Wide-field fundus image from infant ROP screening: 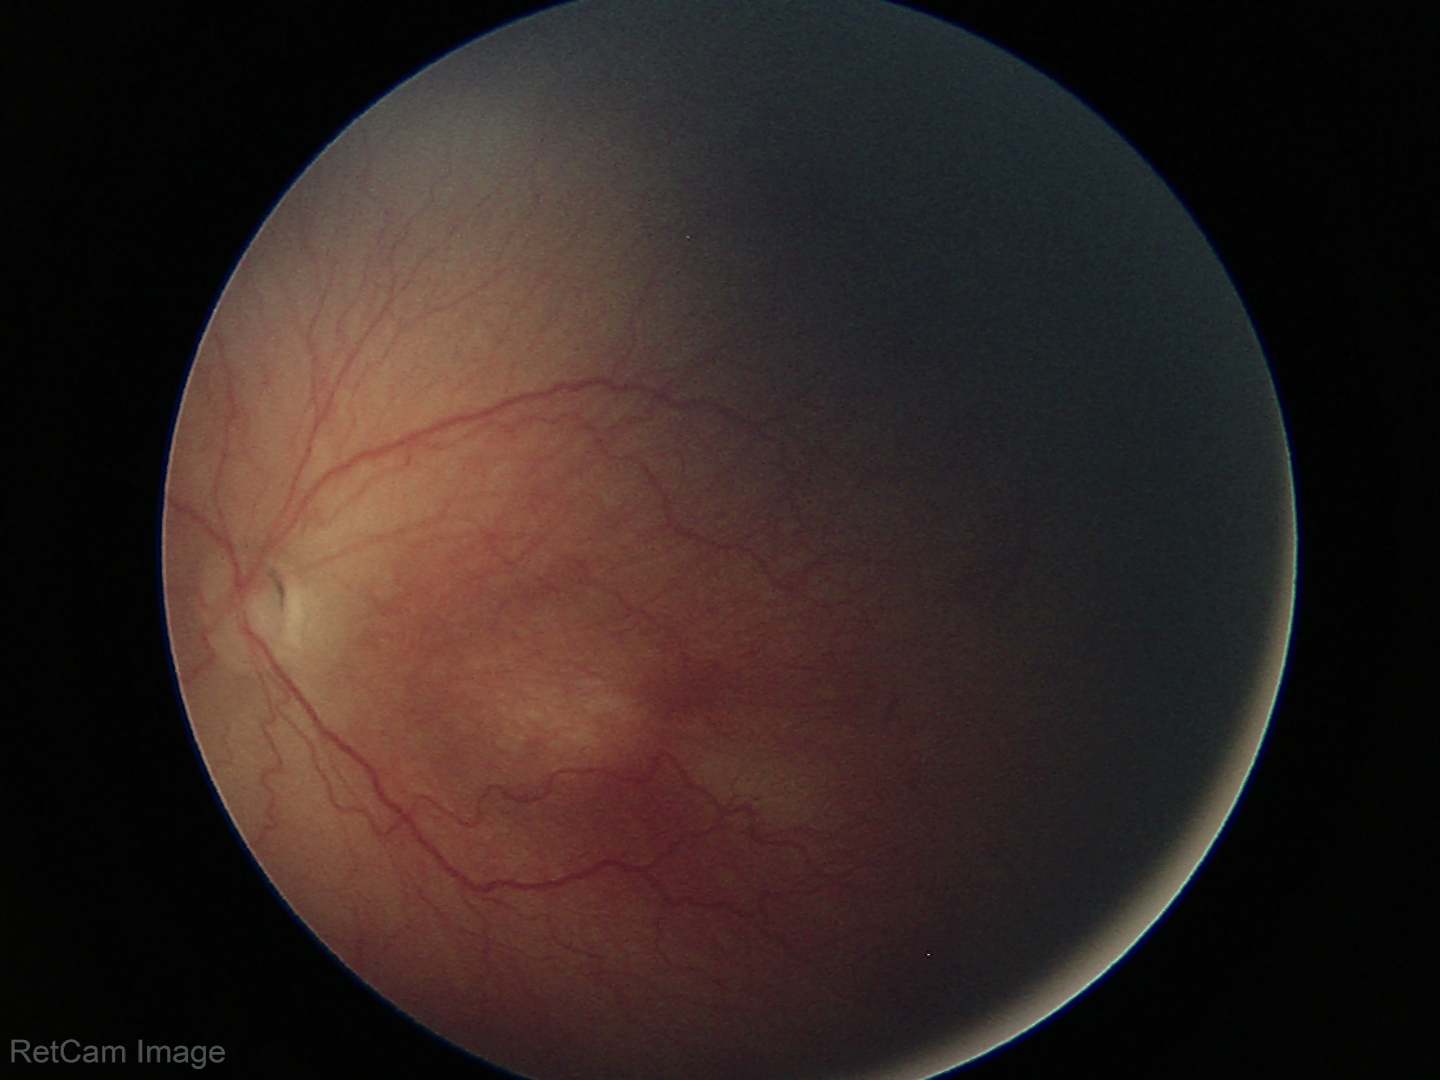

Plus disease = absent
ROP stage = 2